45° FOV — 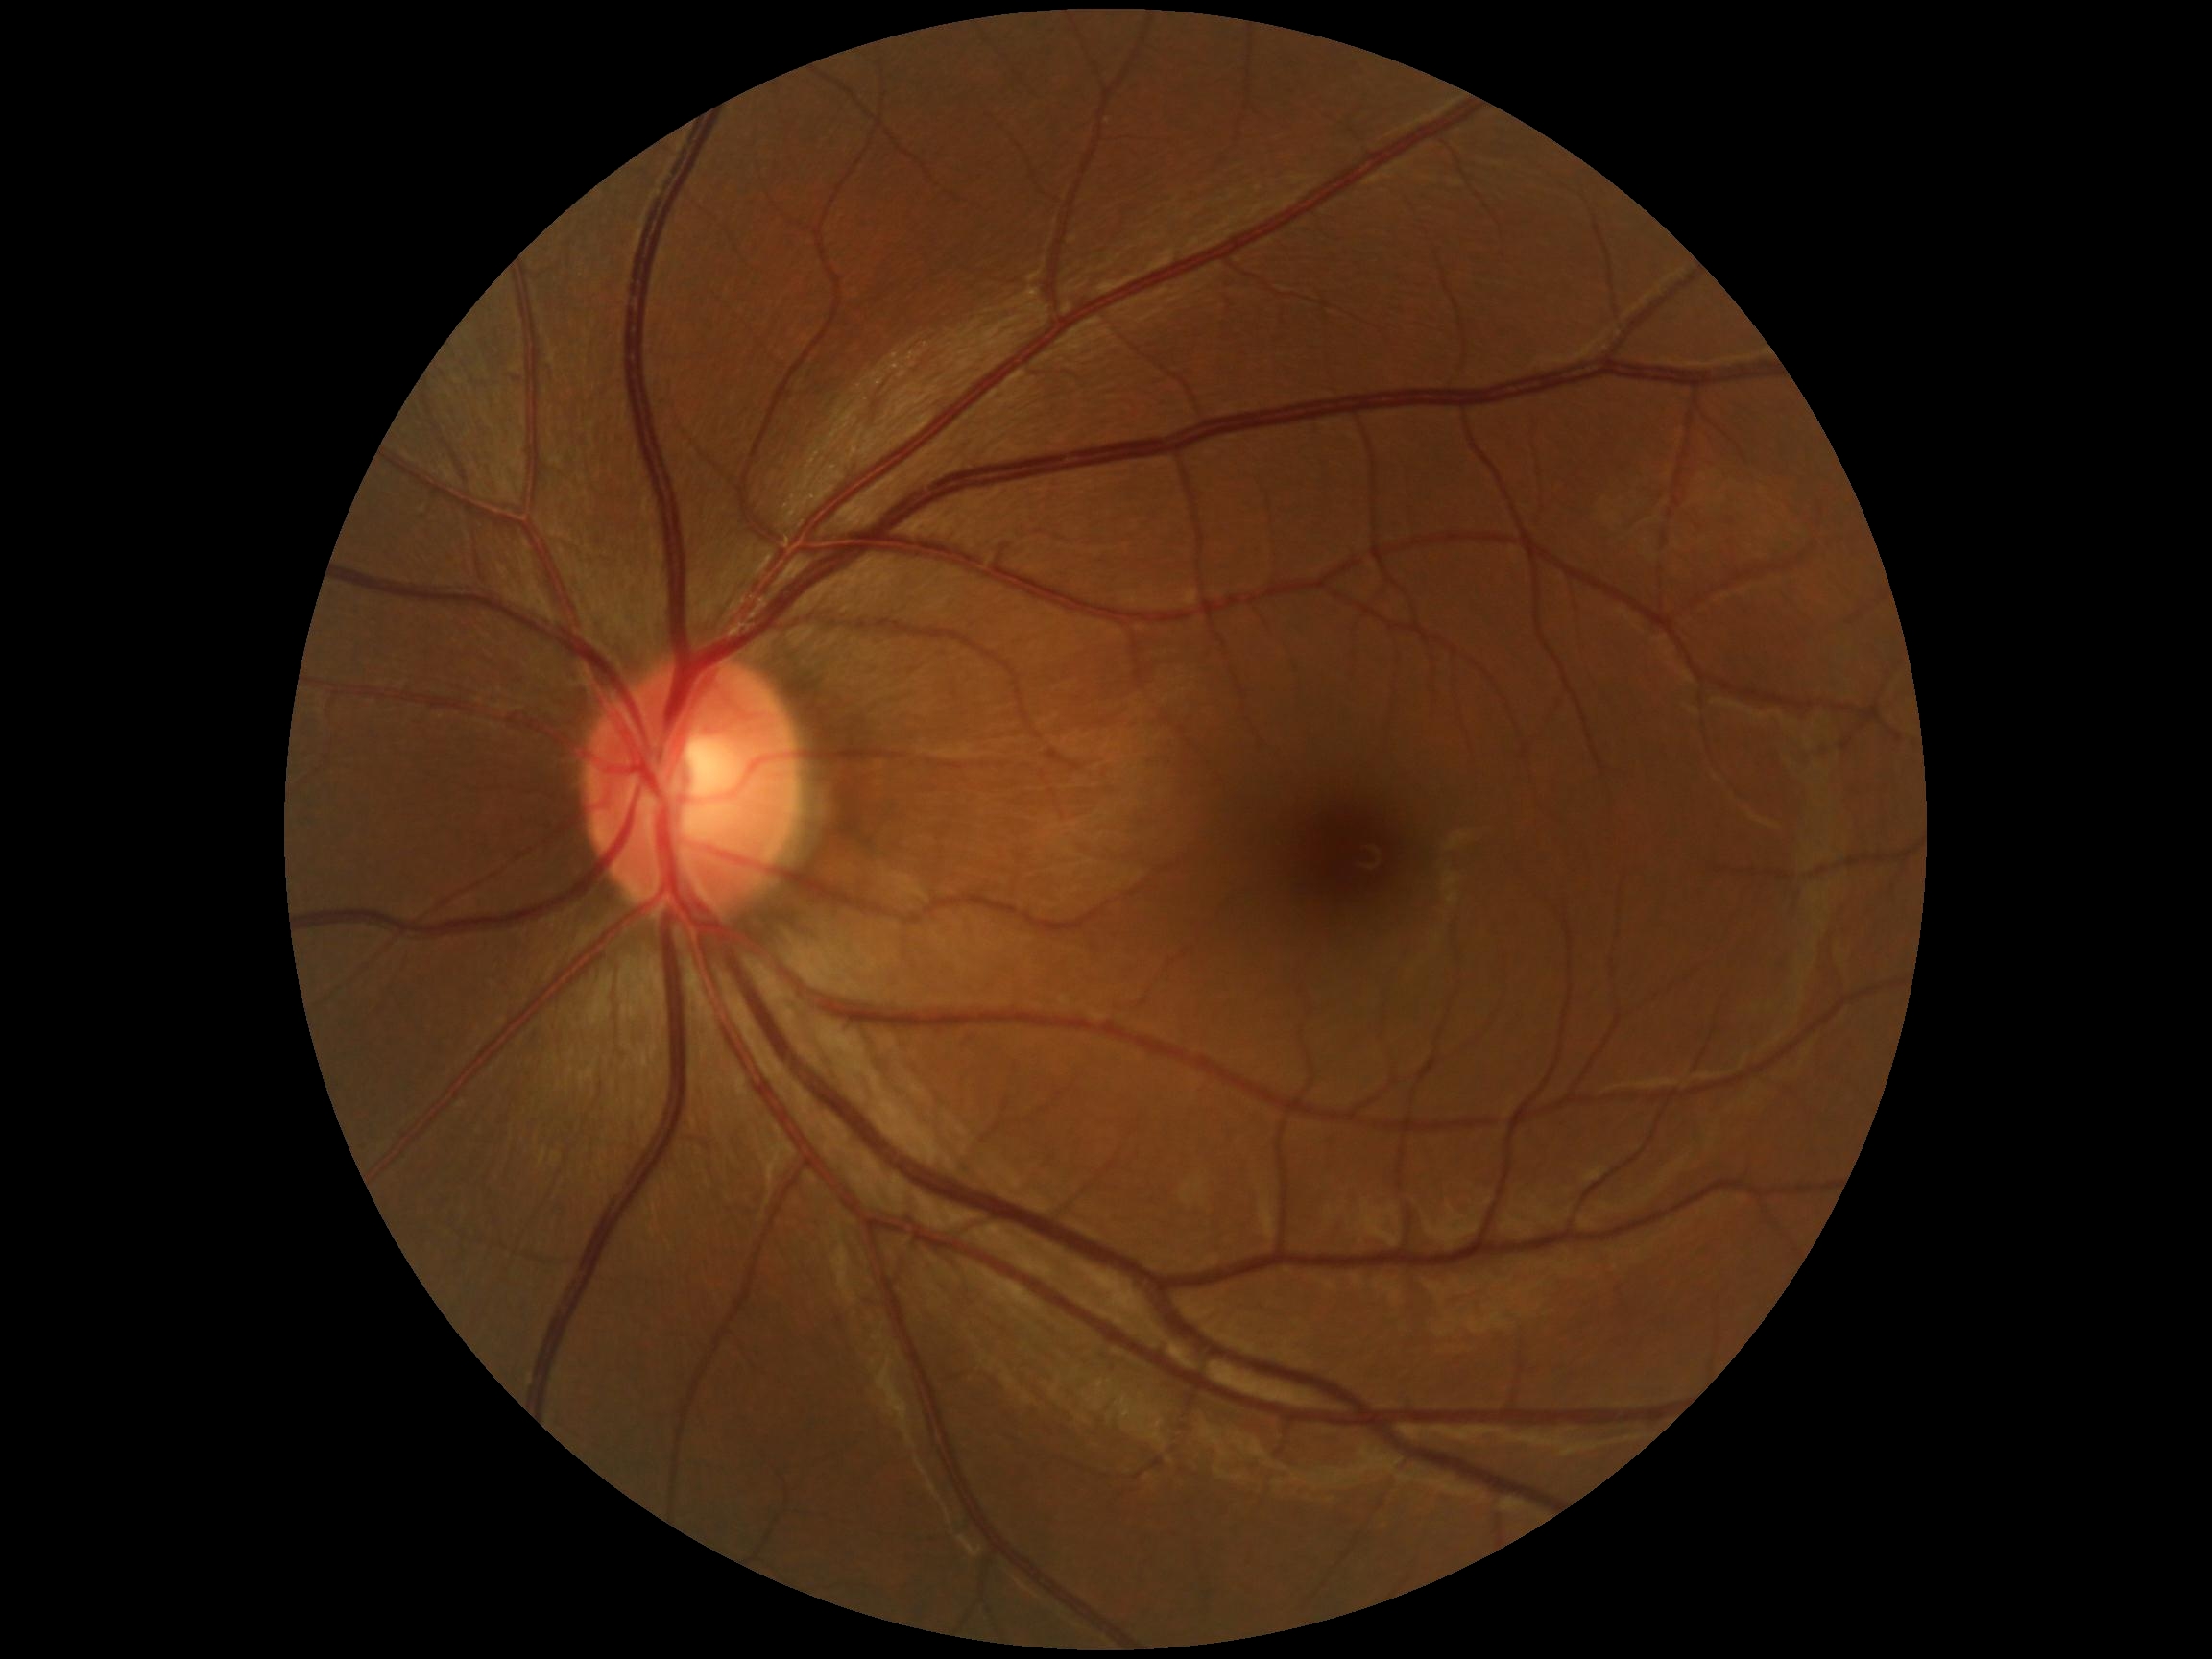
  dr_grade: grade 0 (no apparent retinopathy)